FOV: 45 degrees. Color fundus image: 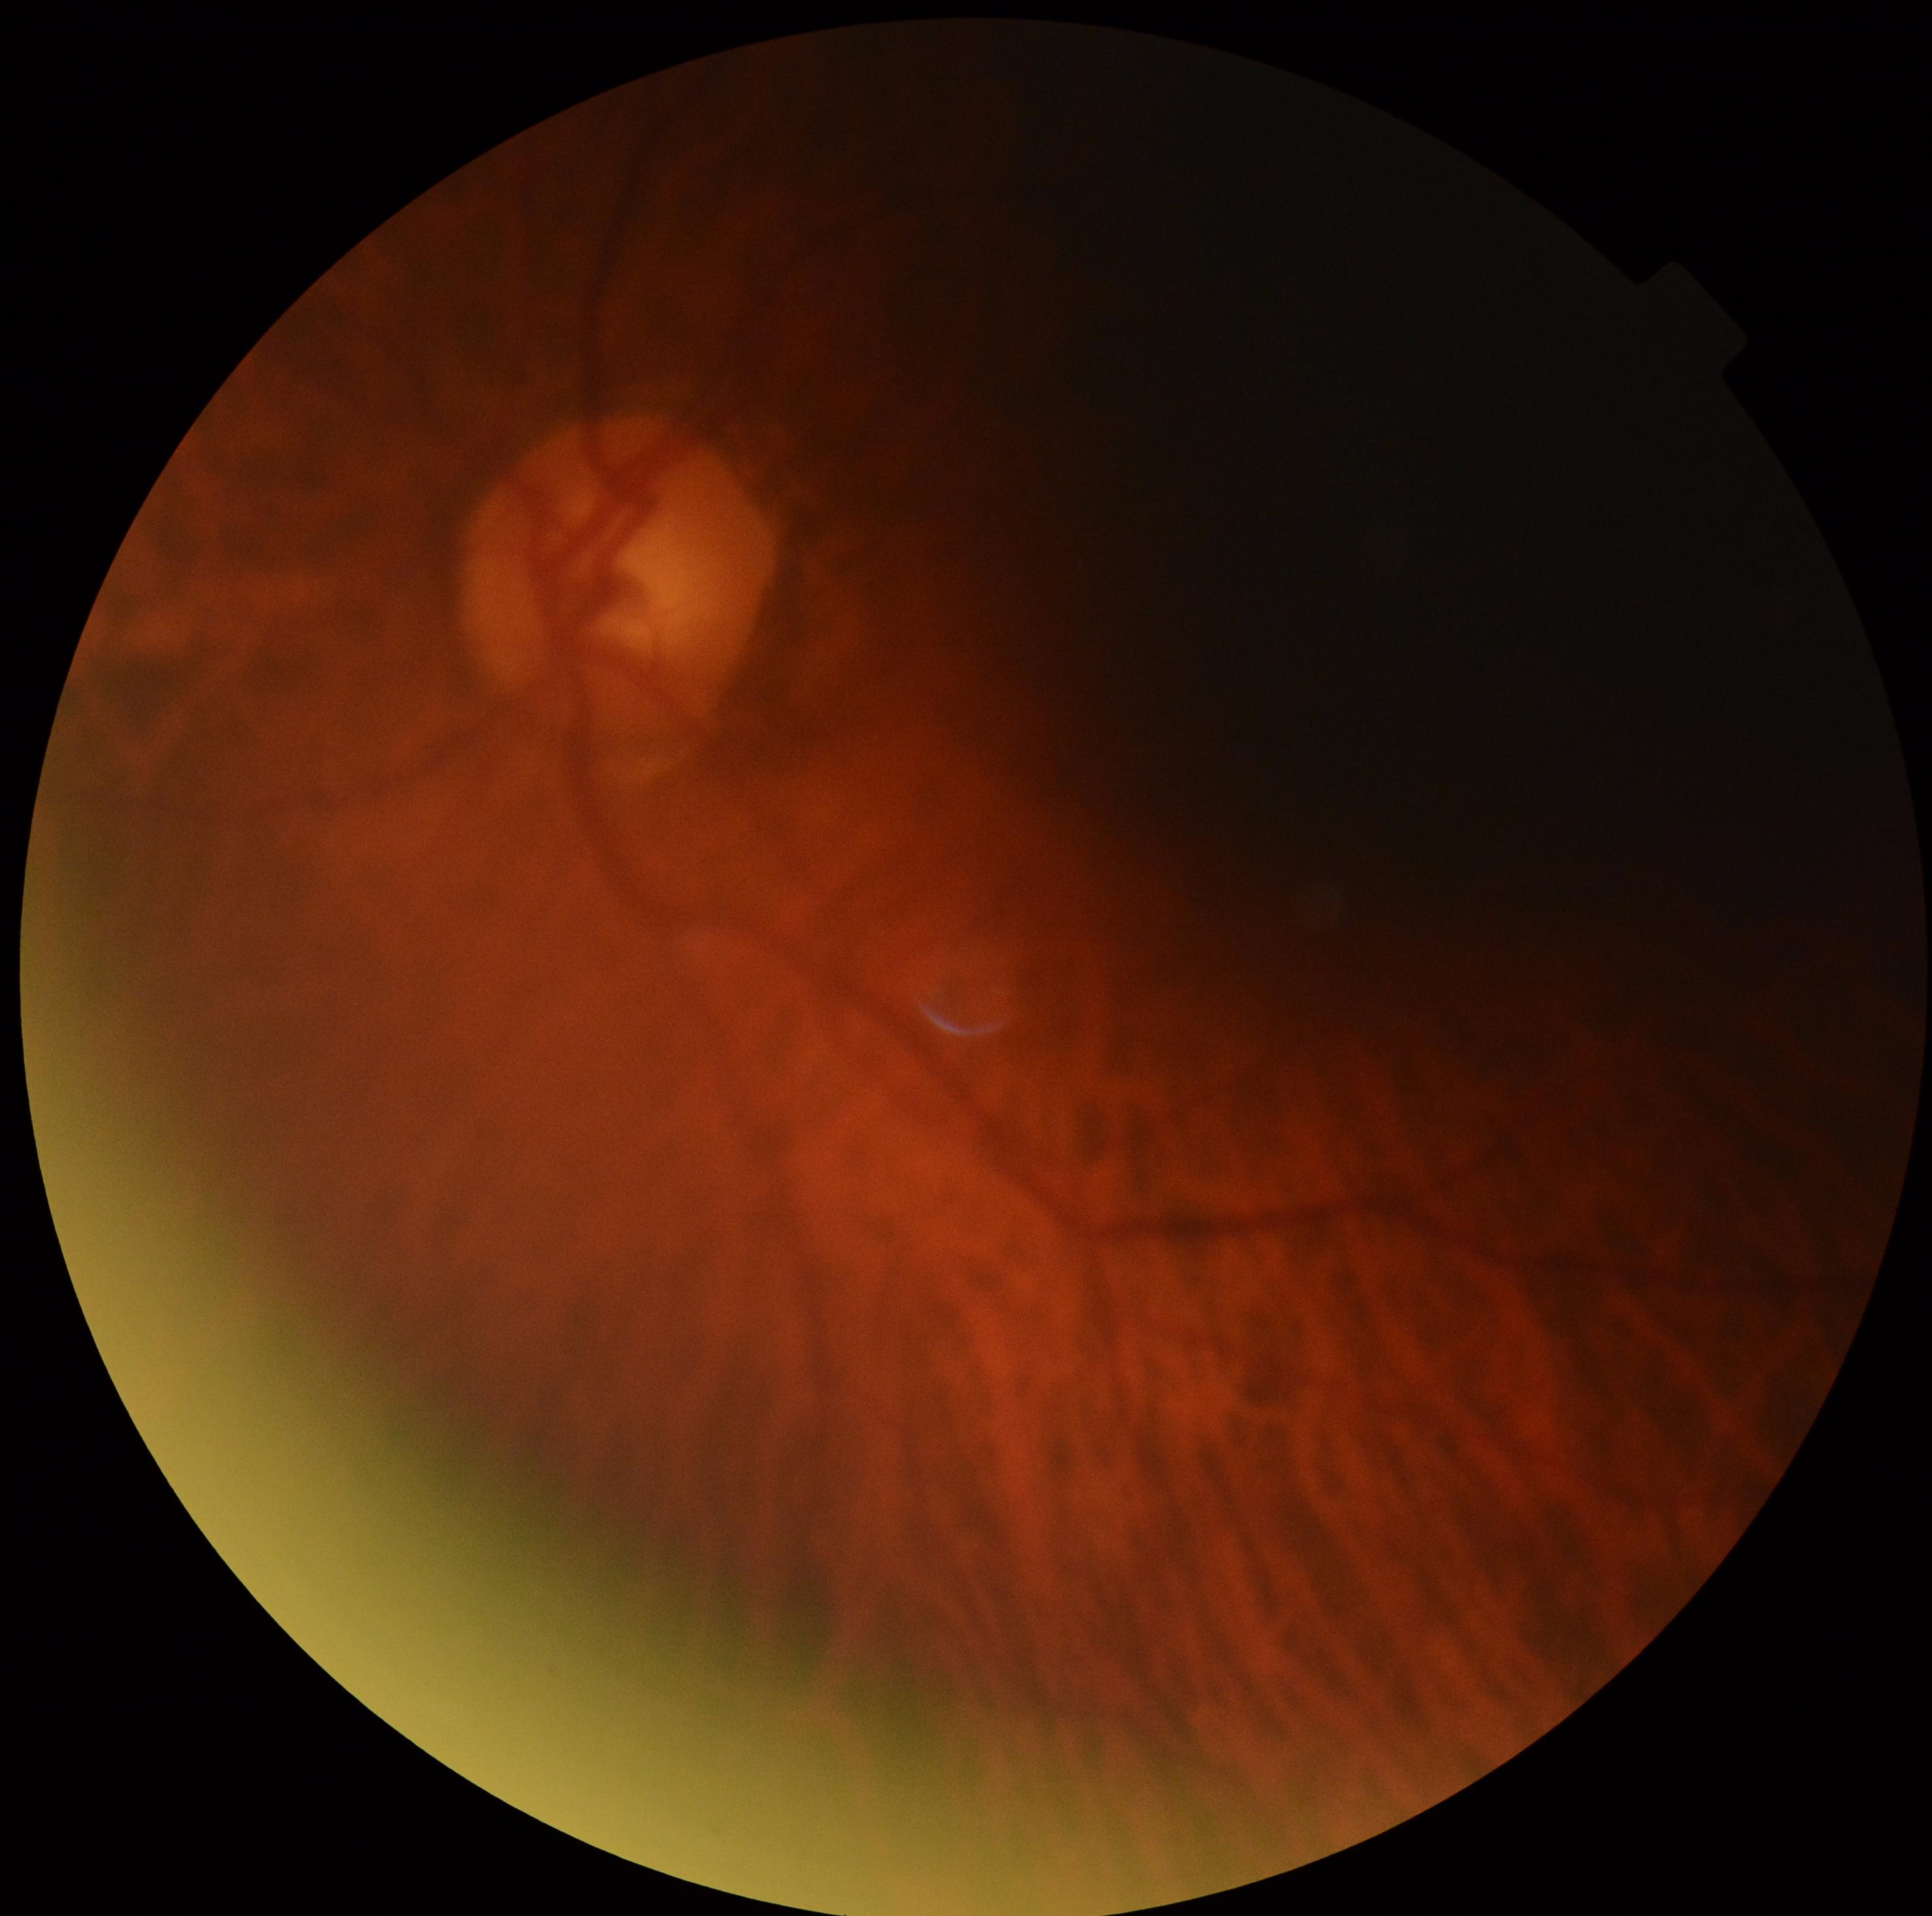

DR stage: grade 0 (no apparent retinopathy).